RetCam wide-field infant fundus image — 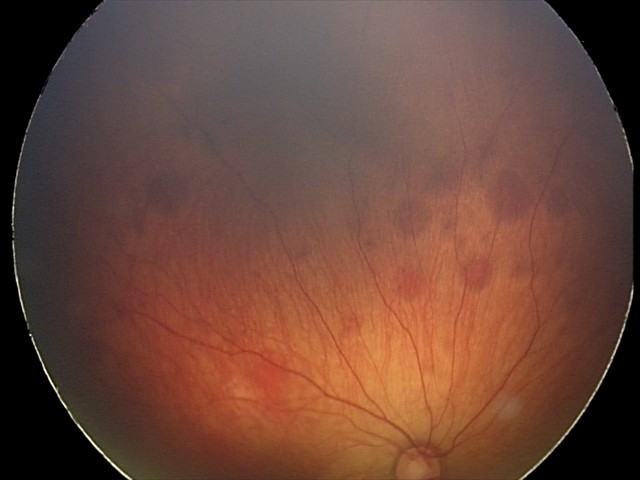

Diagnosis from this screening exam: retinal hemorrhages.